FOV: 45 degrees, 1932x1910px
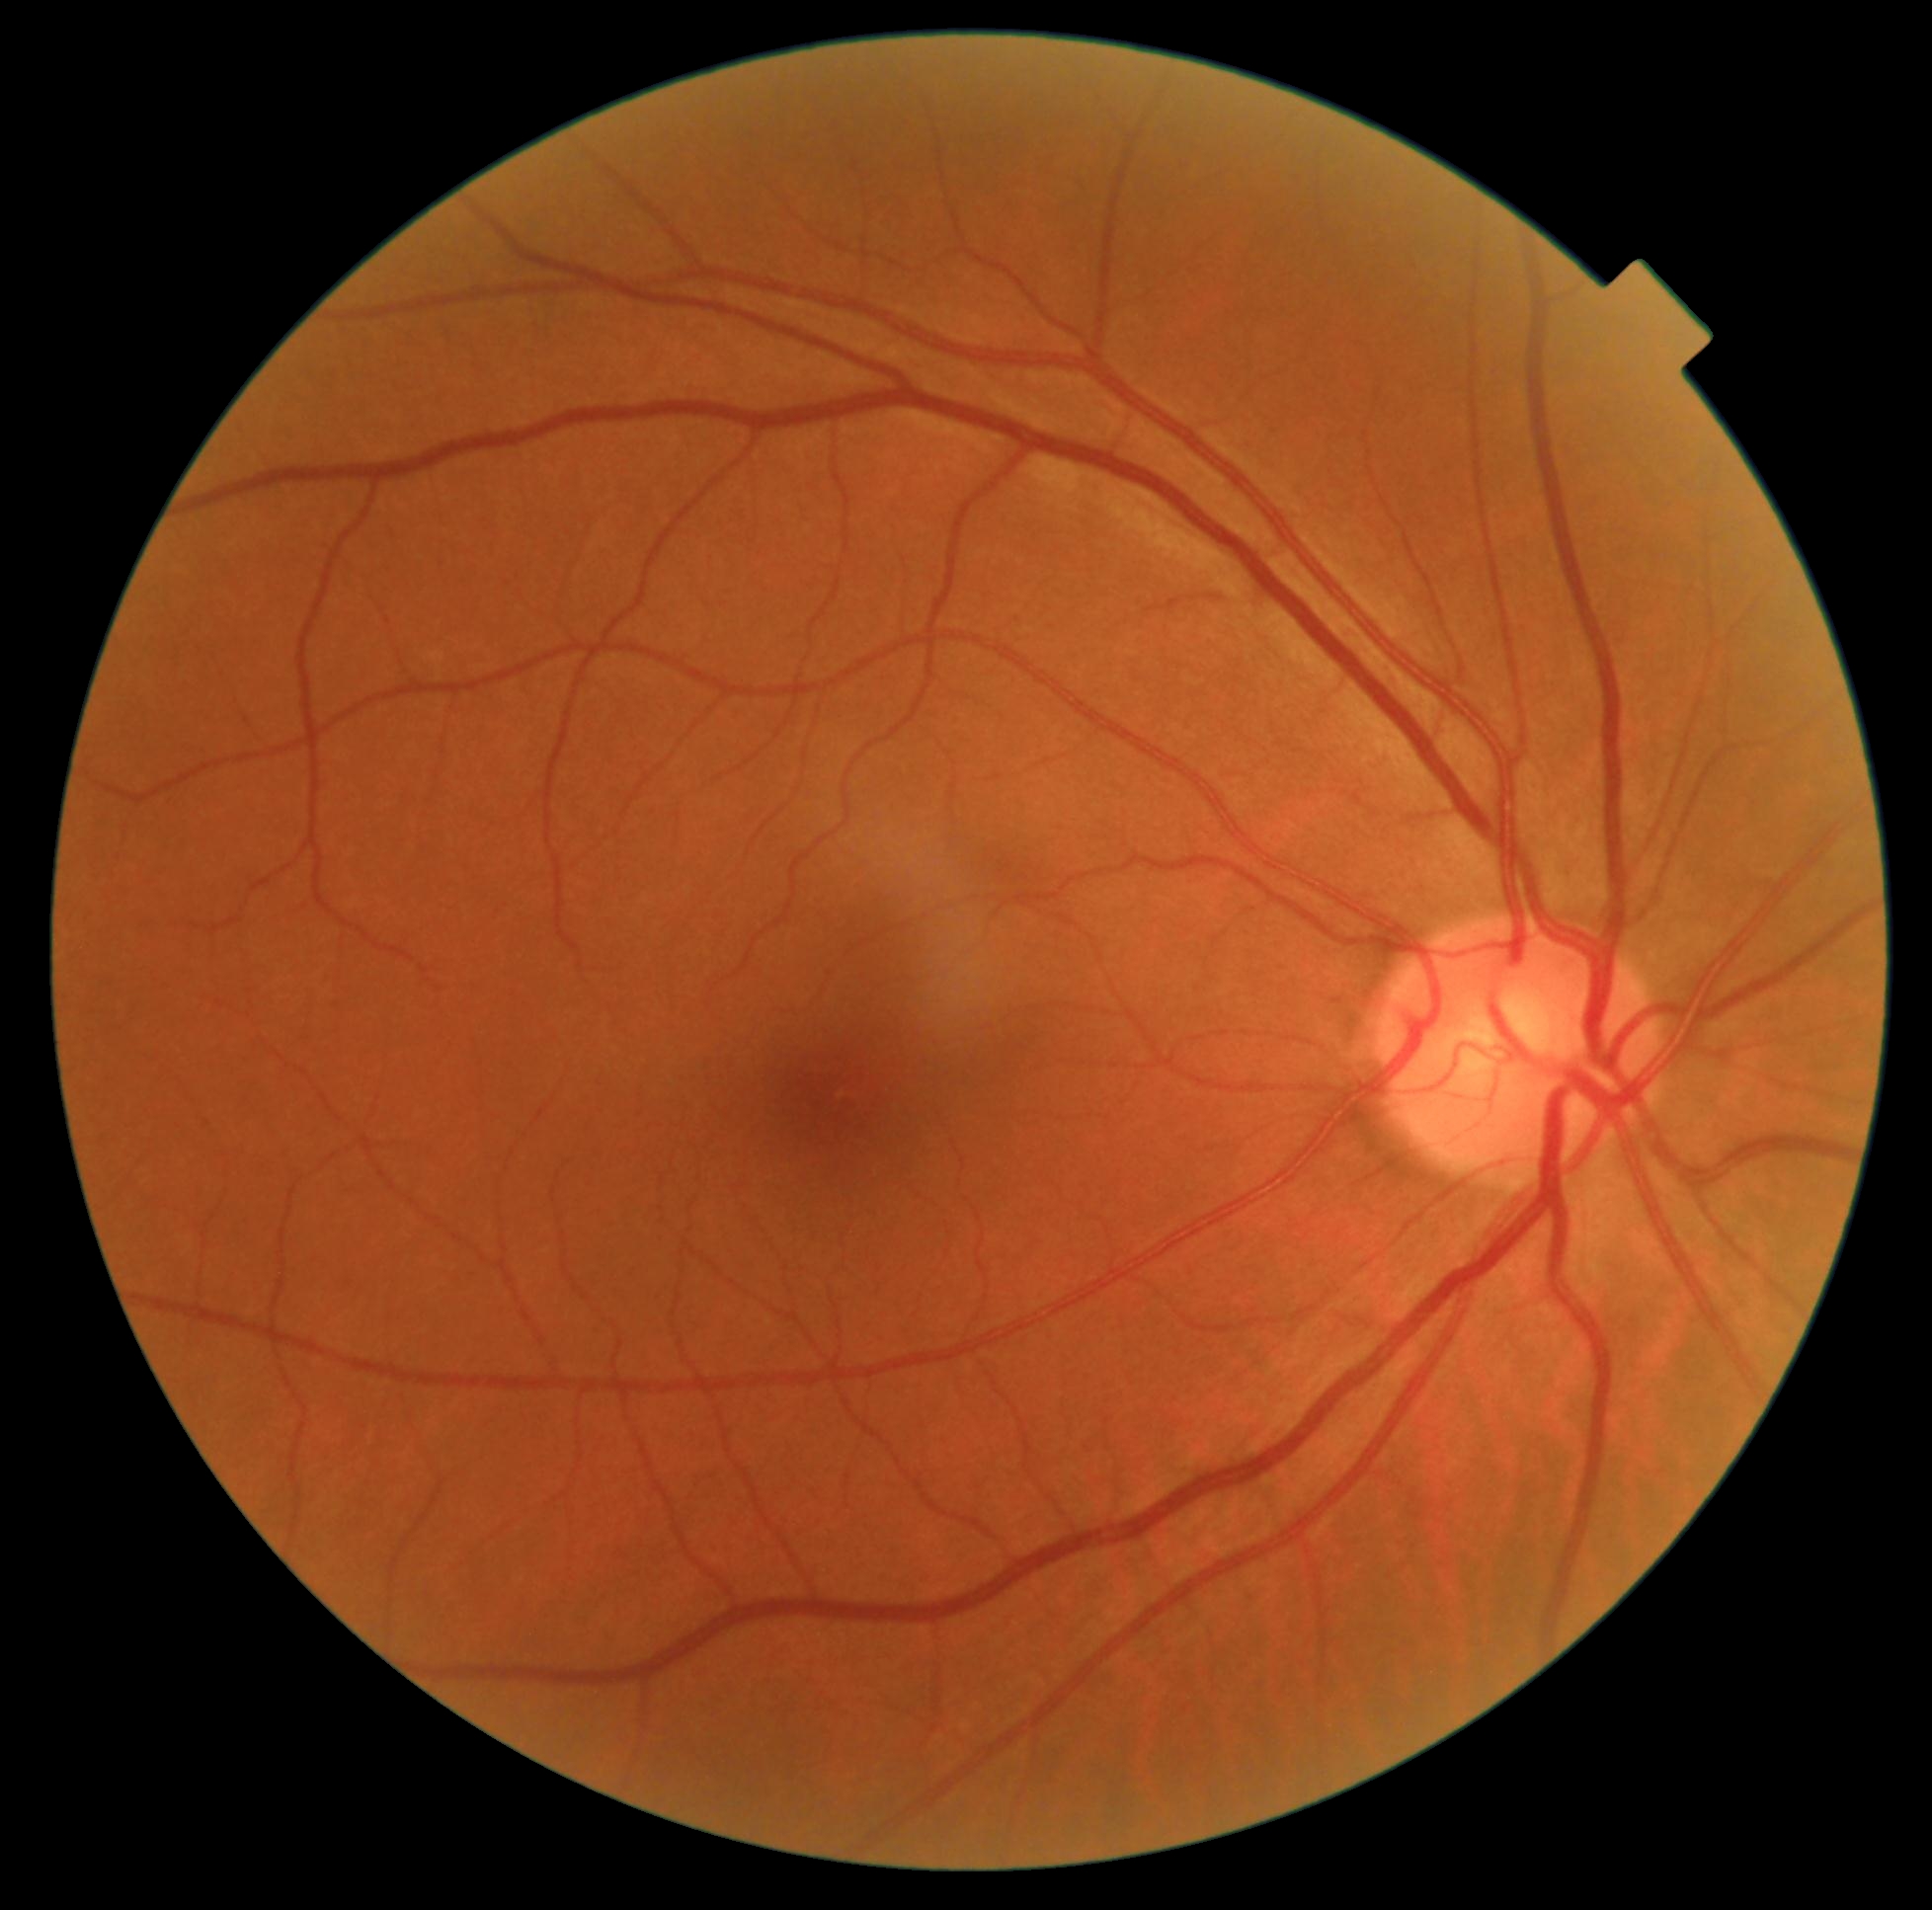
  dr_grade: 0/4 — no visible signs of diabetic retinopathy
  dr_impression: no apparent DR